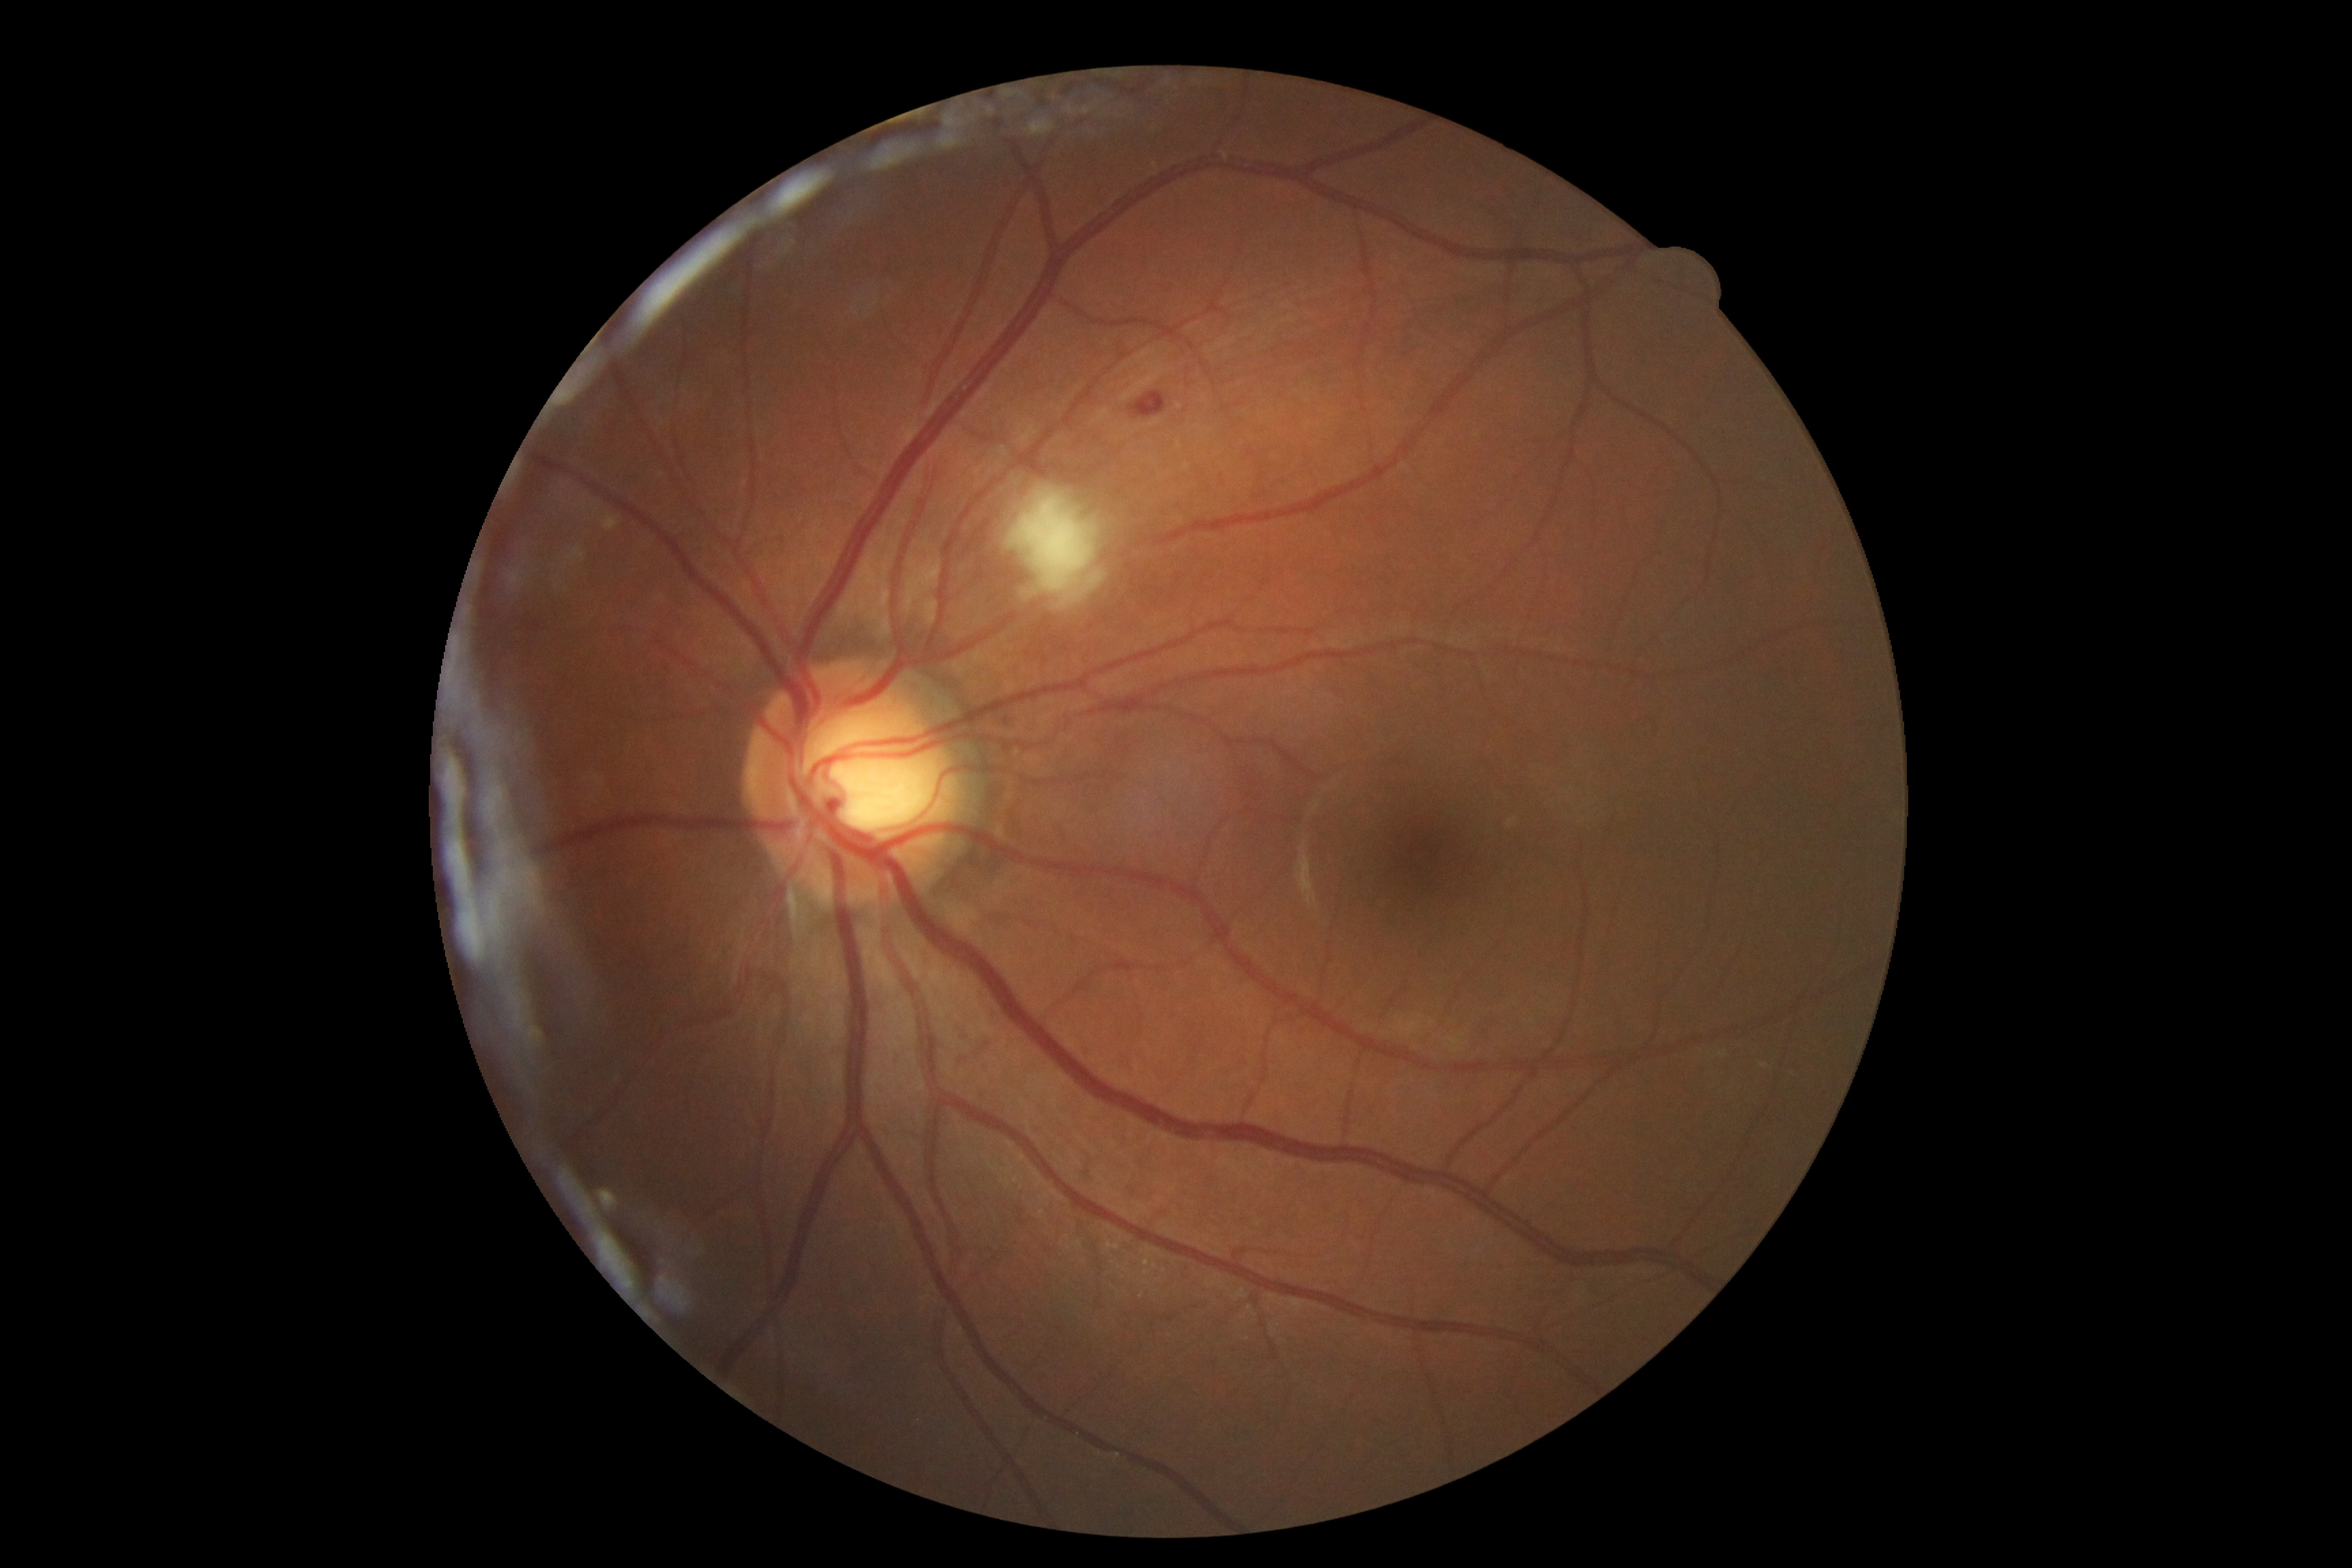 Retinopathy grade is 2.